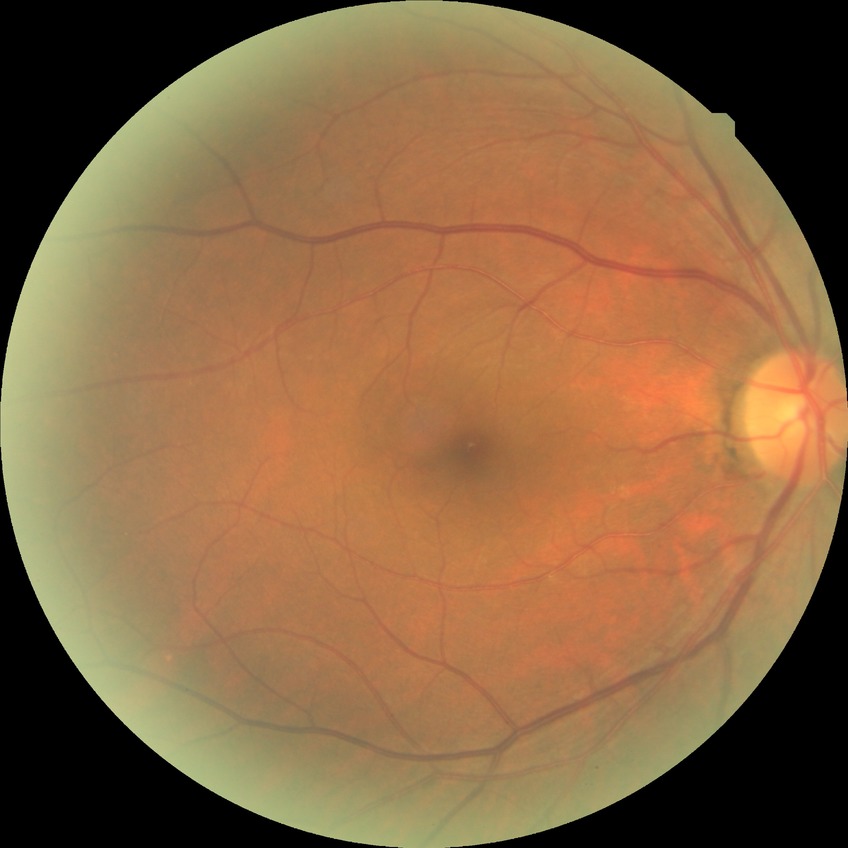

davis_grade: NDR (no diabetic retinopathy)